Pediatric retinal photograph (wide-field): 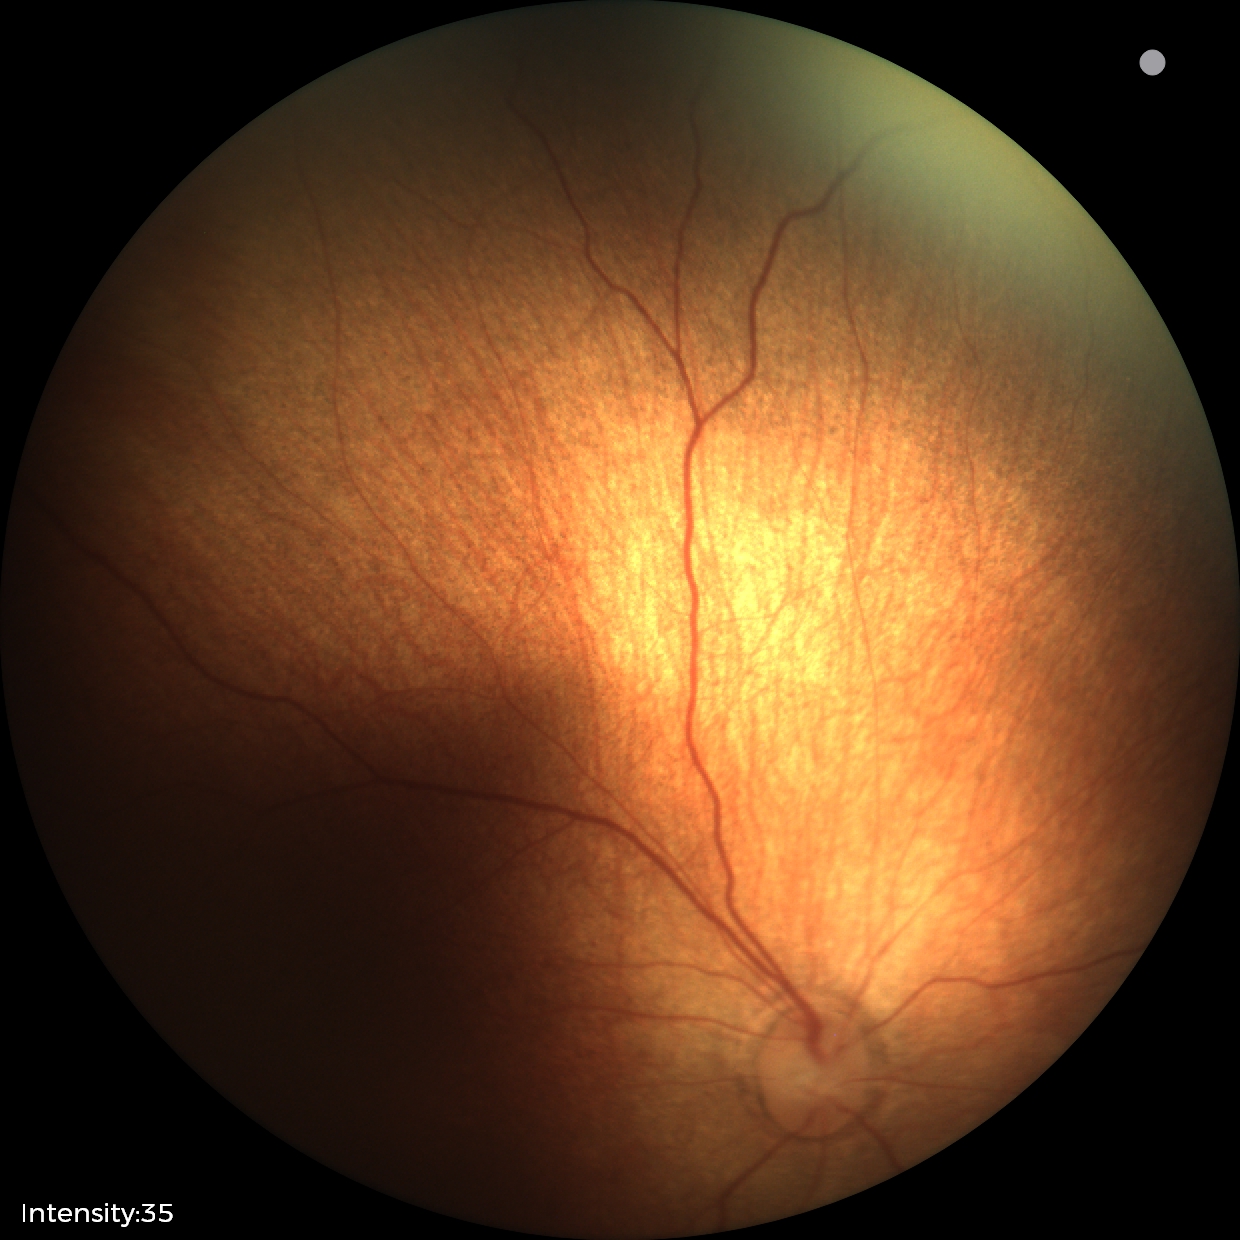

Examination with physiological retinal findings.